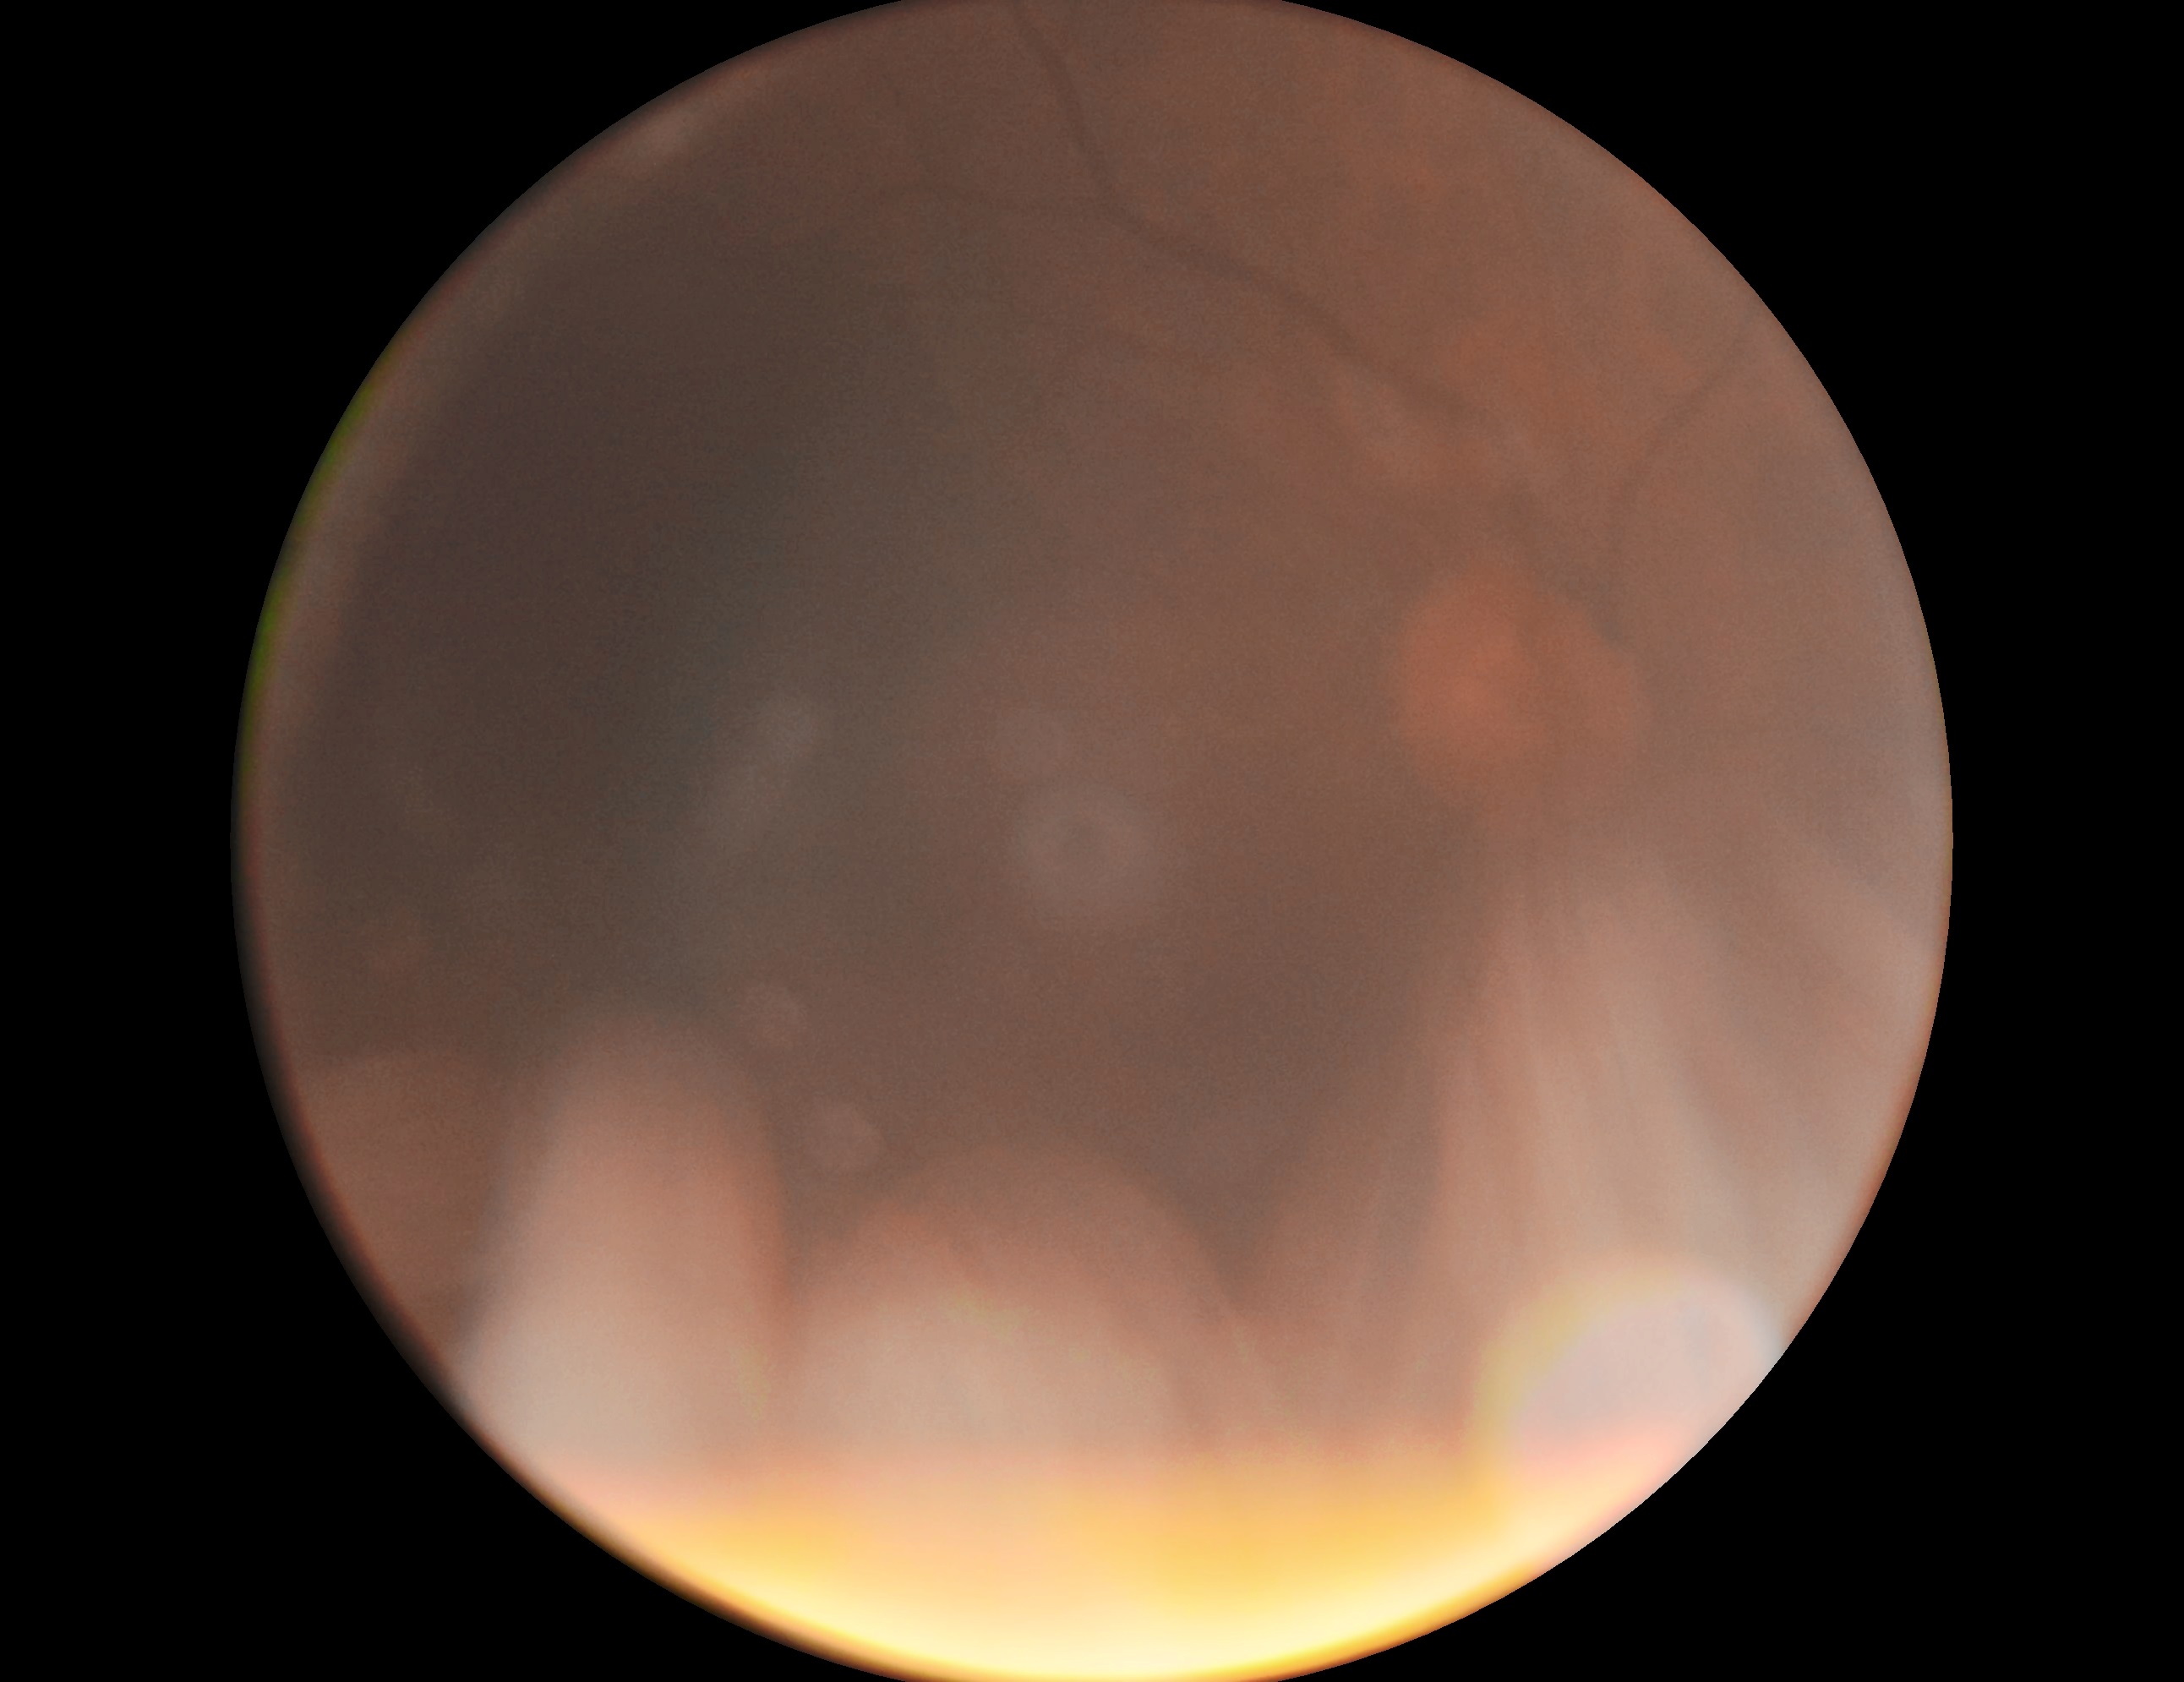 DR: ungradable. Ungradable image — DR severity cannot be determined.